45° field of view. 2352x1568 — 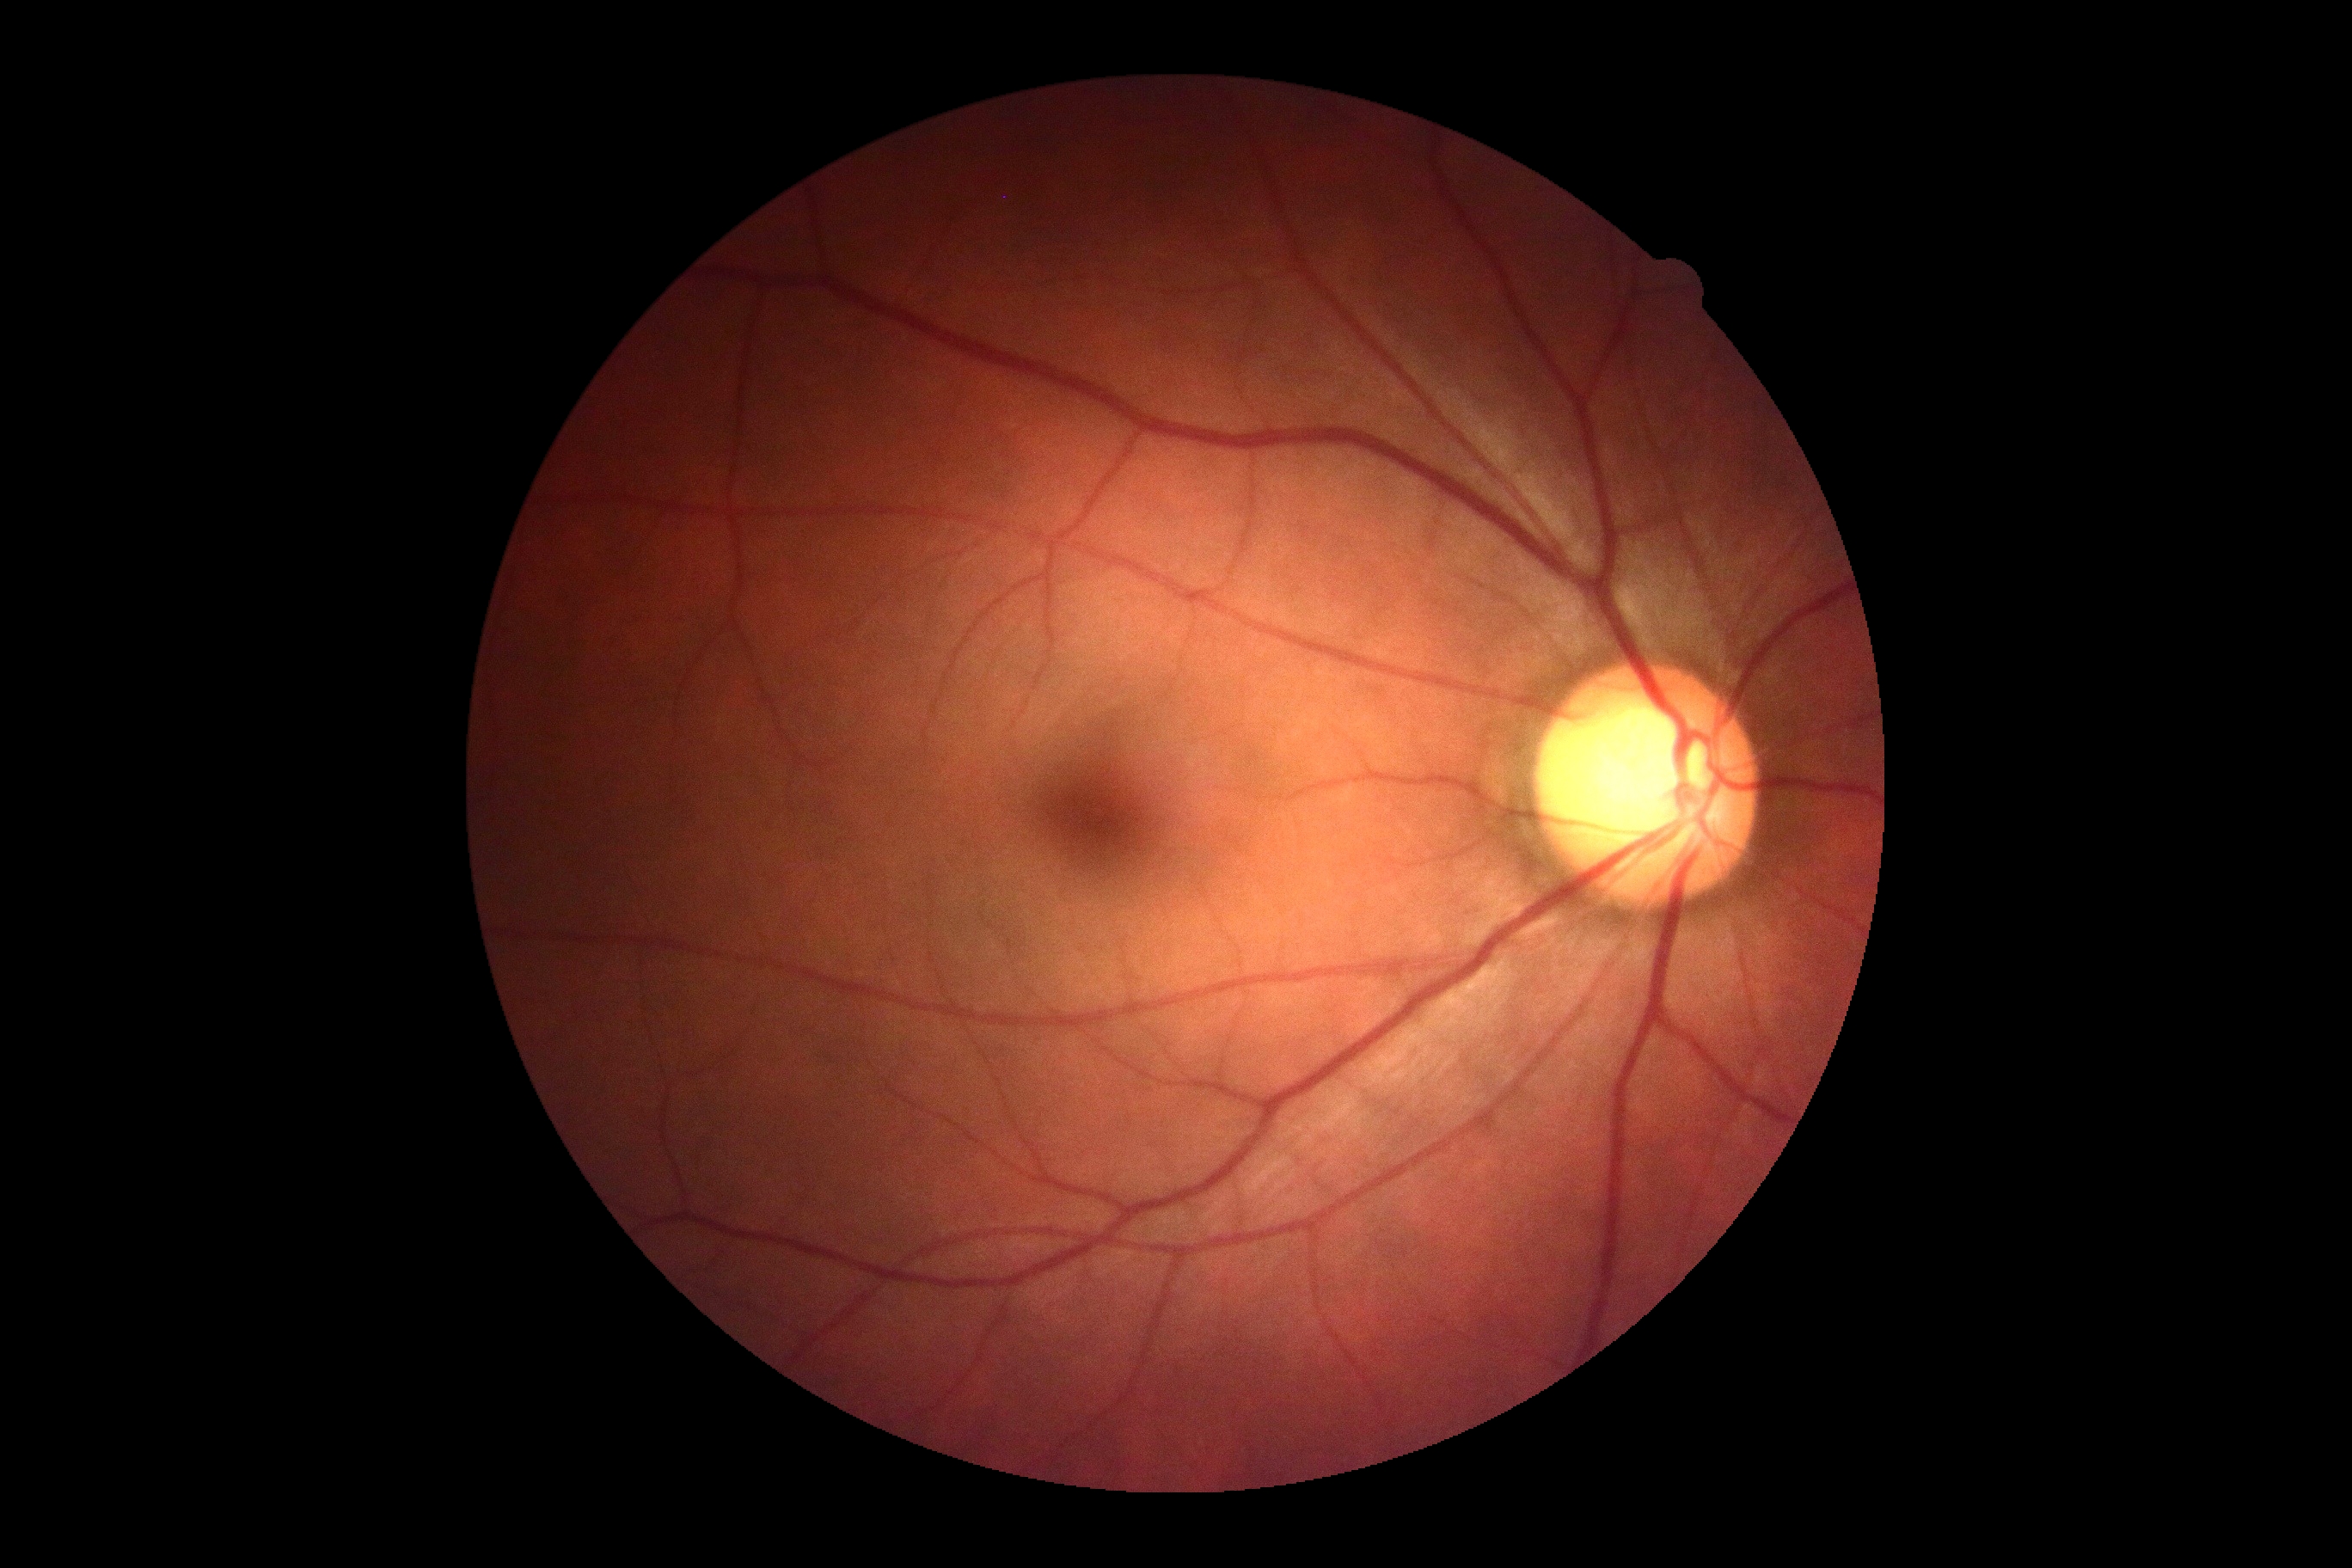
diabetic retinopathy = grade 0 (no apparent retinopathy) — no visible signs of diabetic retinopathy.